2352x1568
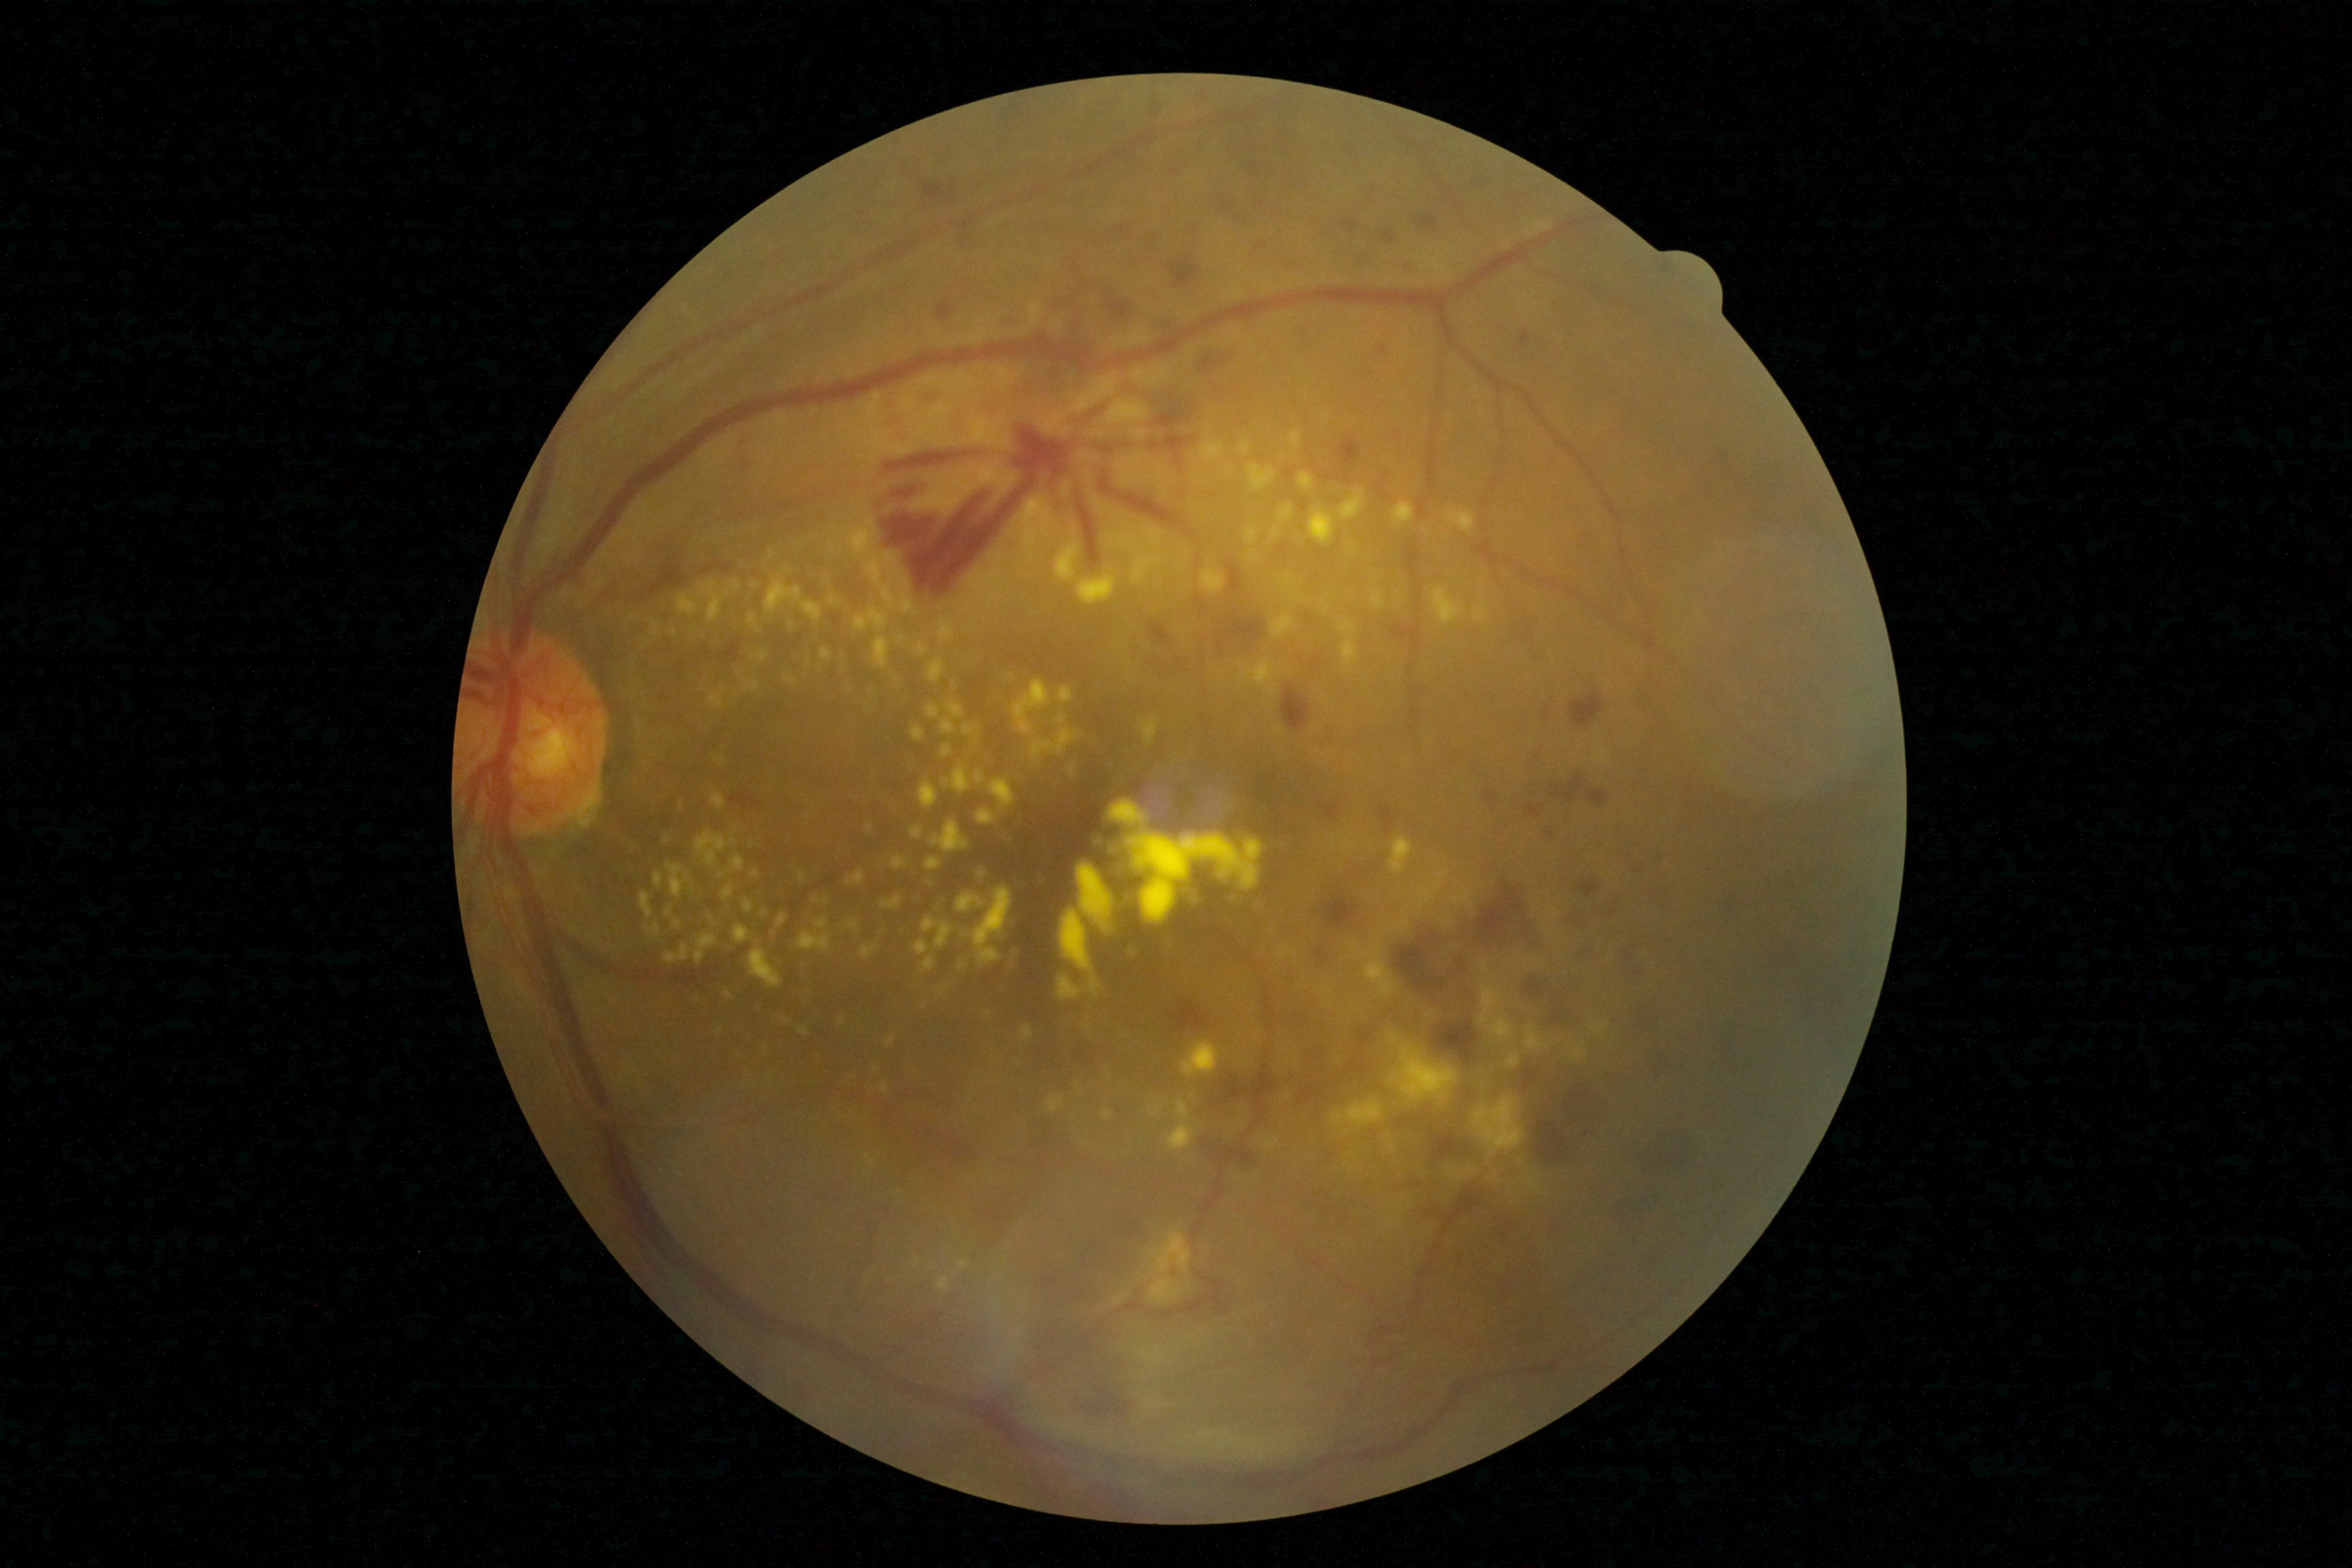 Diabetic retinopathy severity: PDR (grade 4).